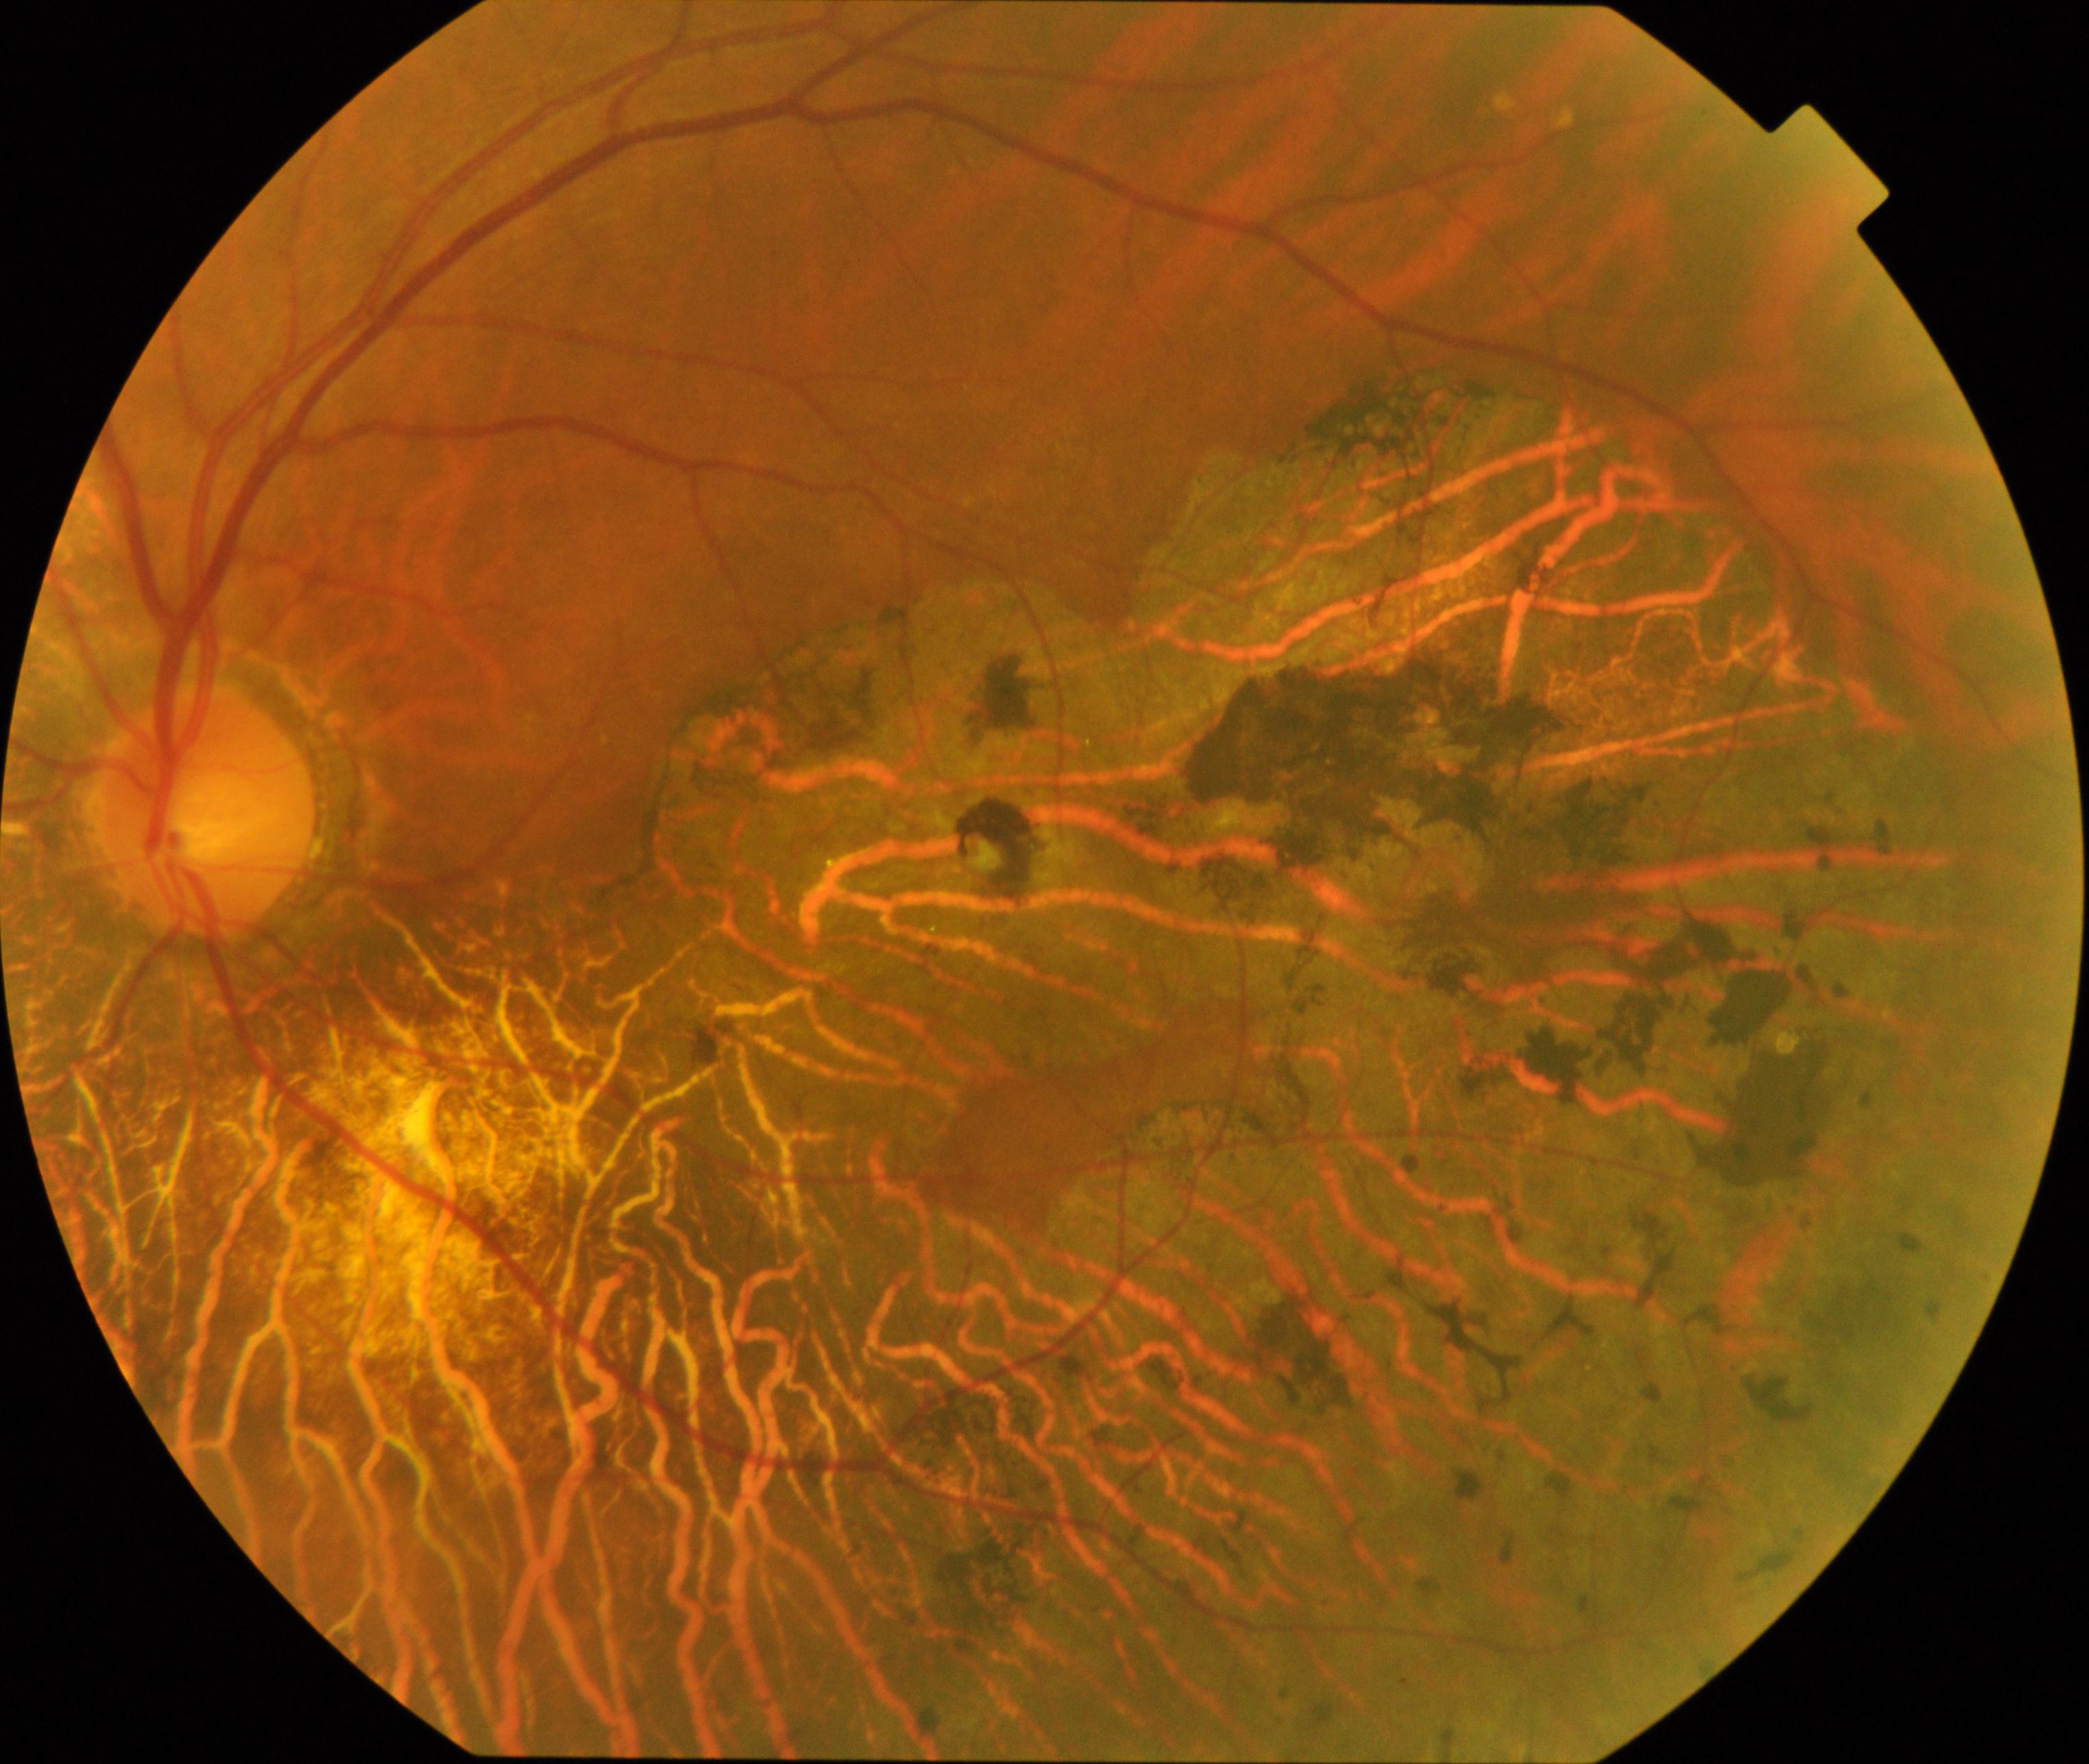
This fundus photograph shows chorioretinal atrophy or coloboma. Characterized by focal or extensive retinal pigment epithelium and choroidal atrophy or coloboma.